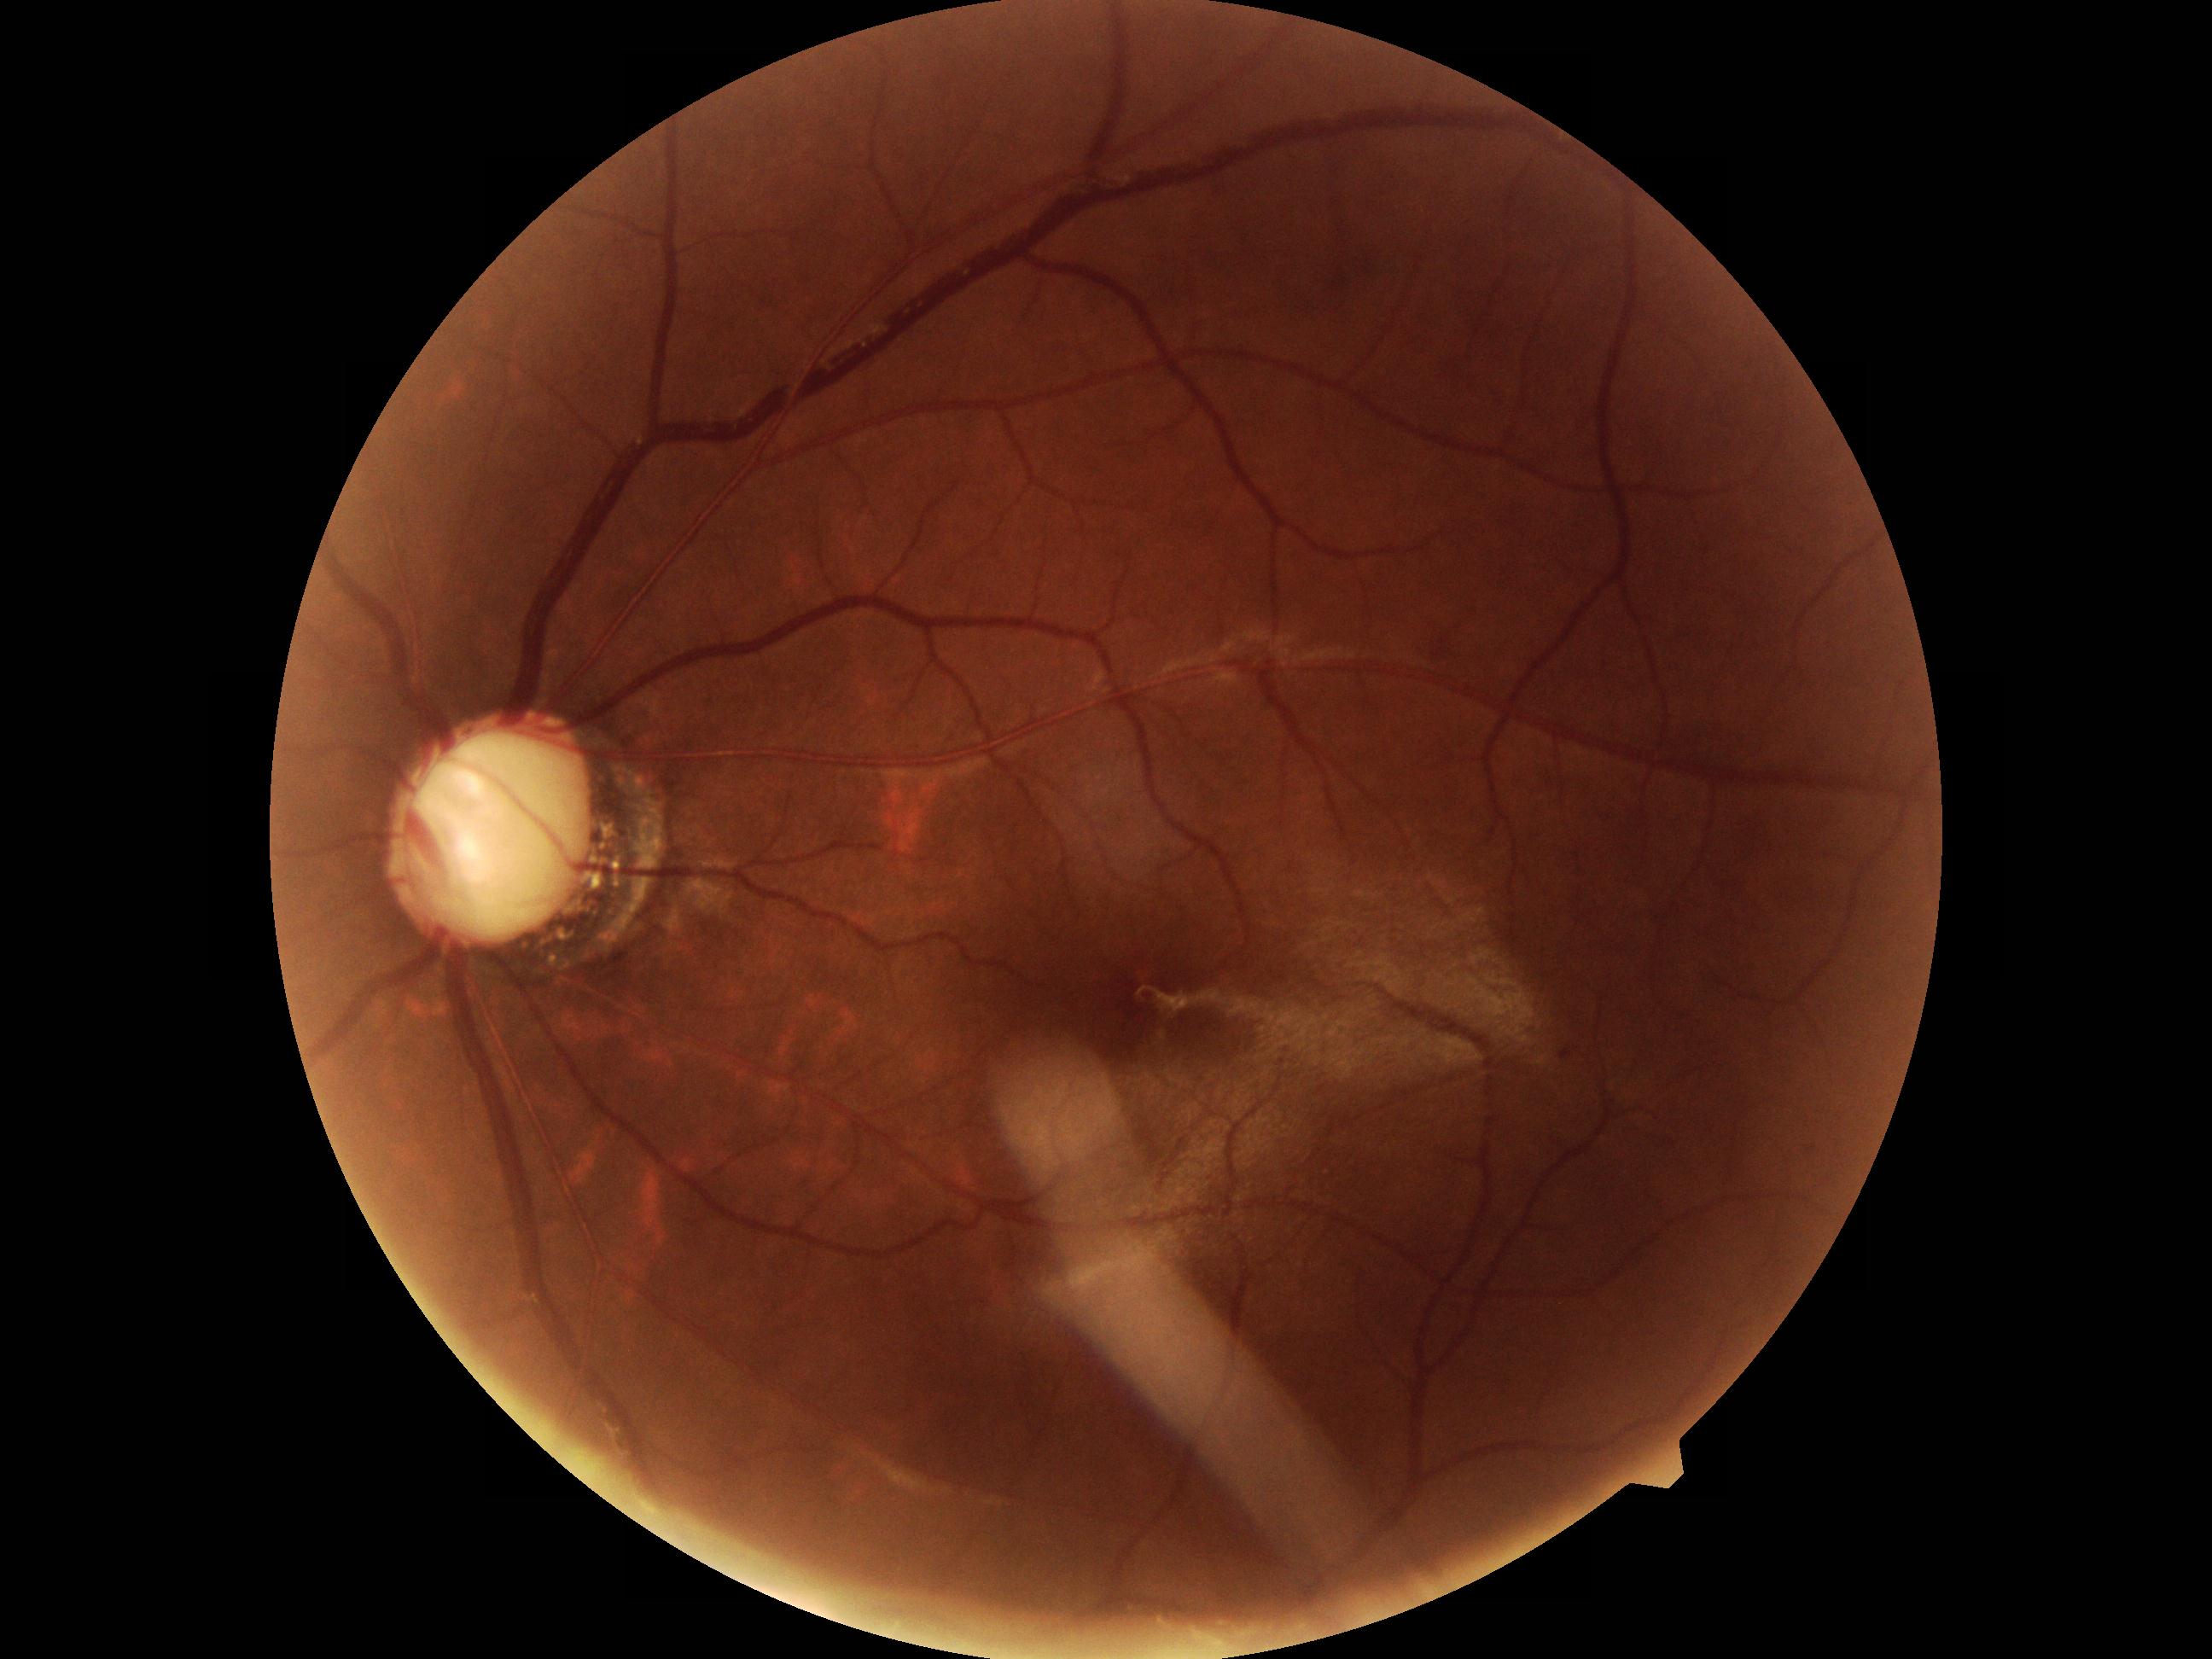 There is evidence of possible glaucoma.